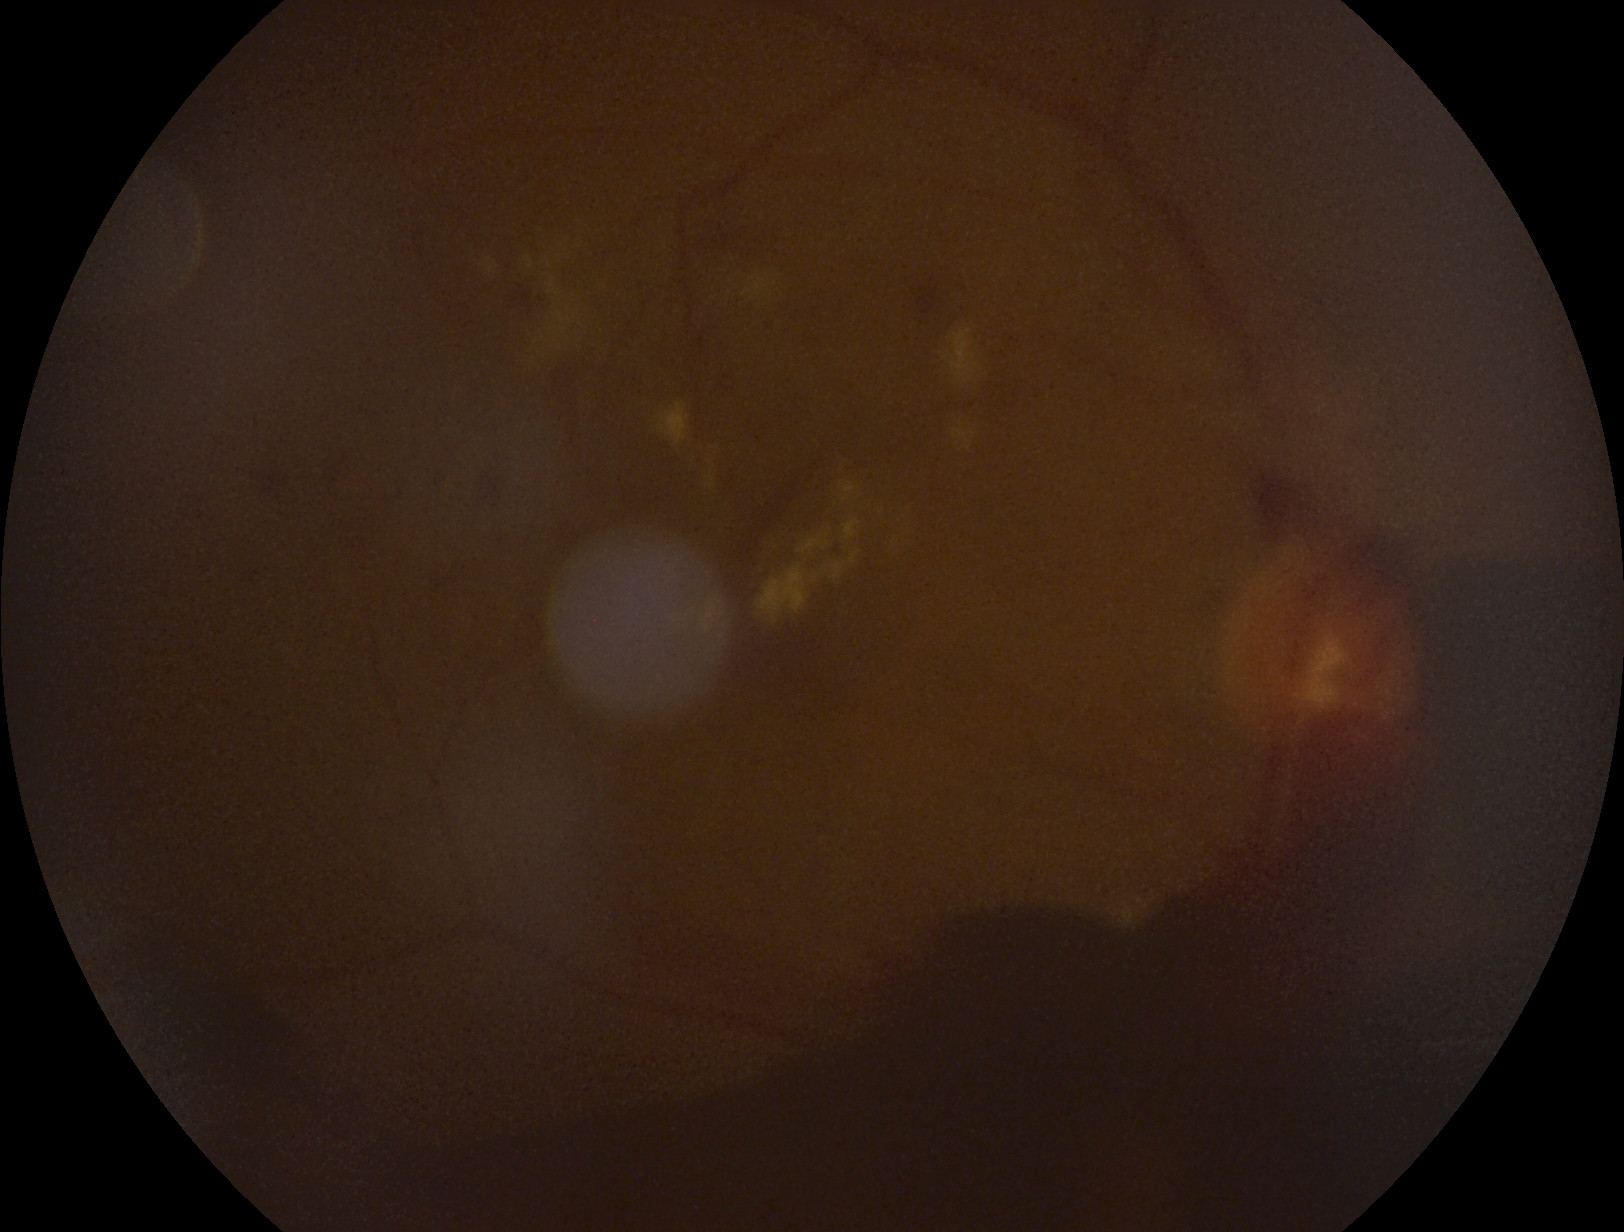

The retinopathy is classified as proliferative diabetic retinopathy. Diabetic retinopathy (DR): proliferative diabetic retinopathy (grade 4).